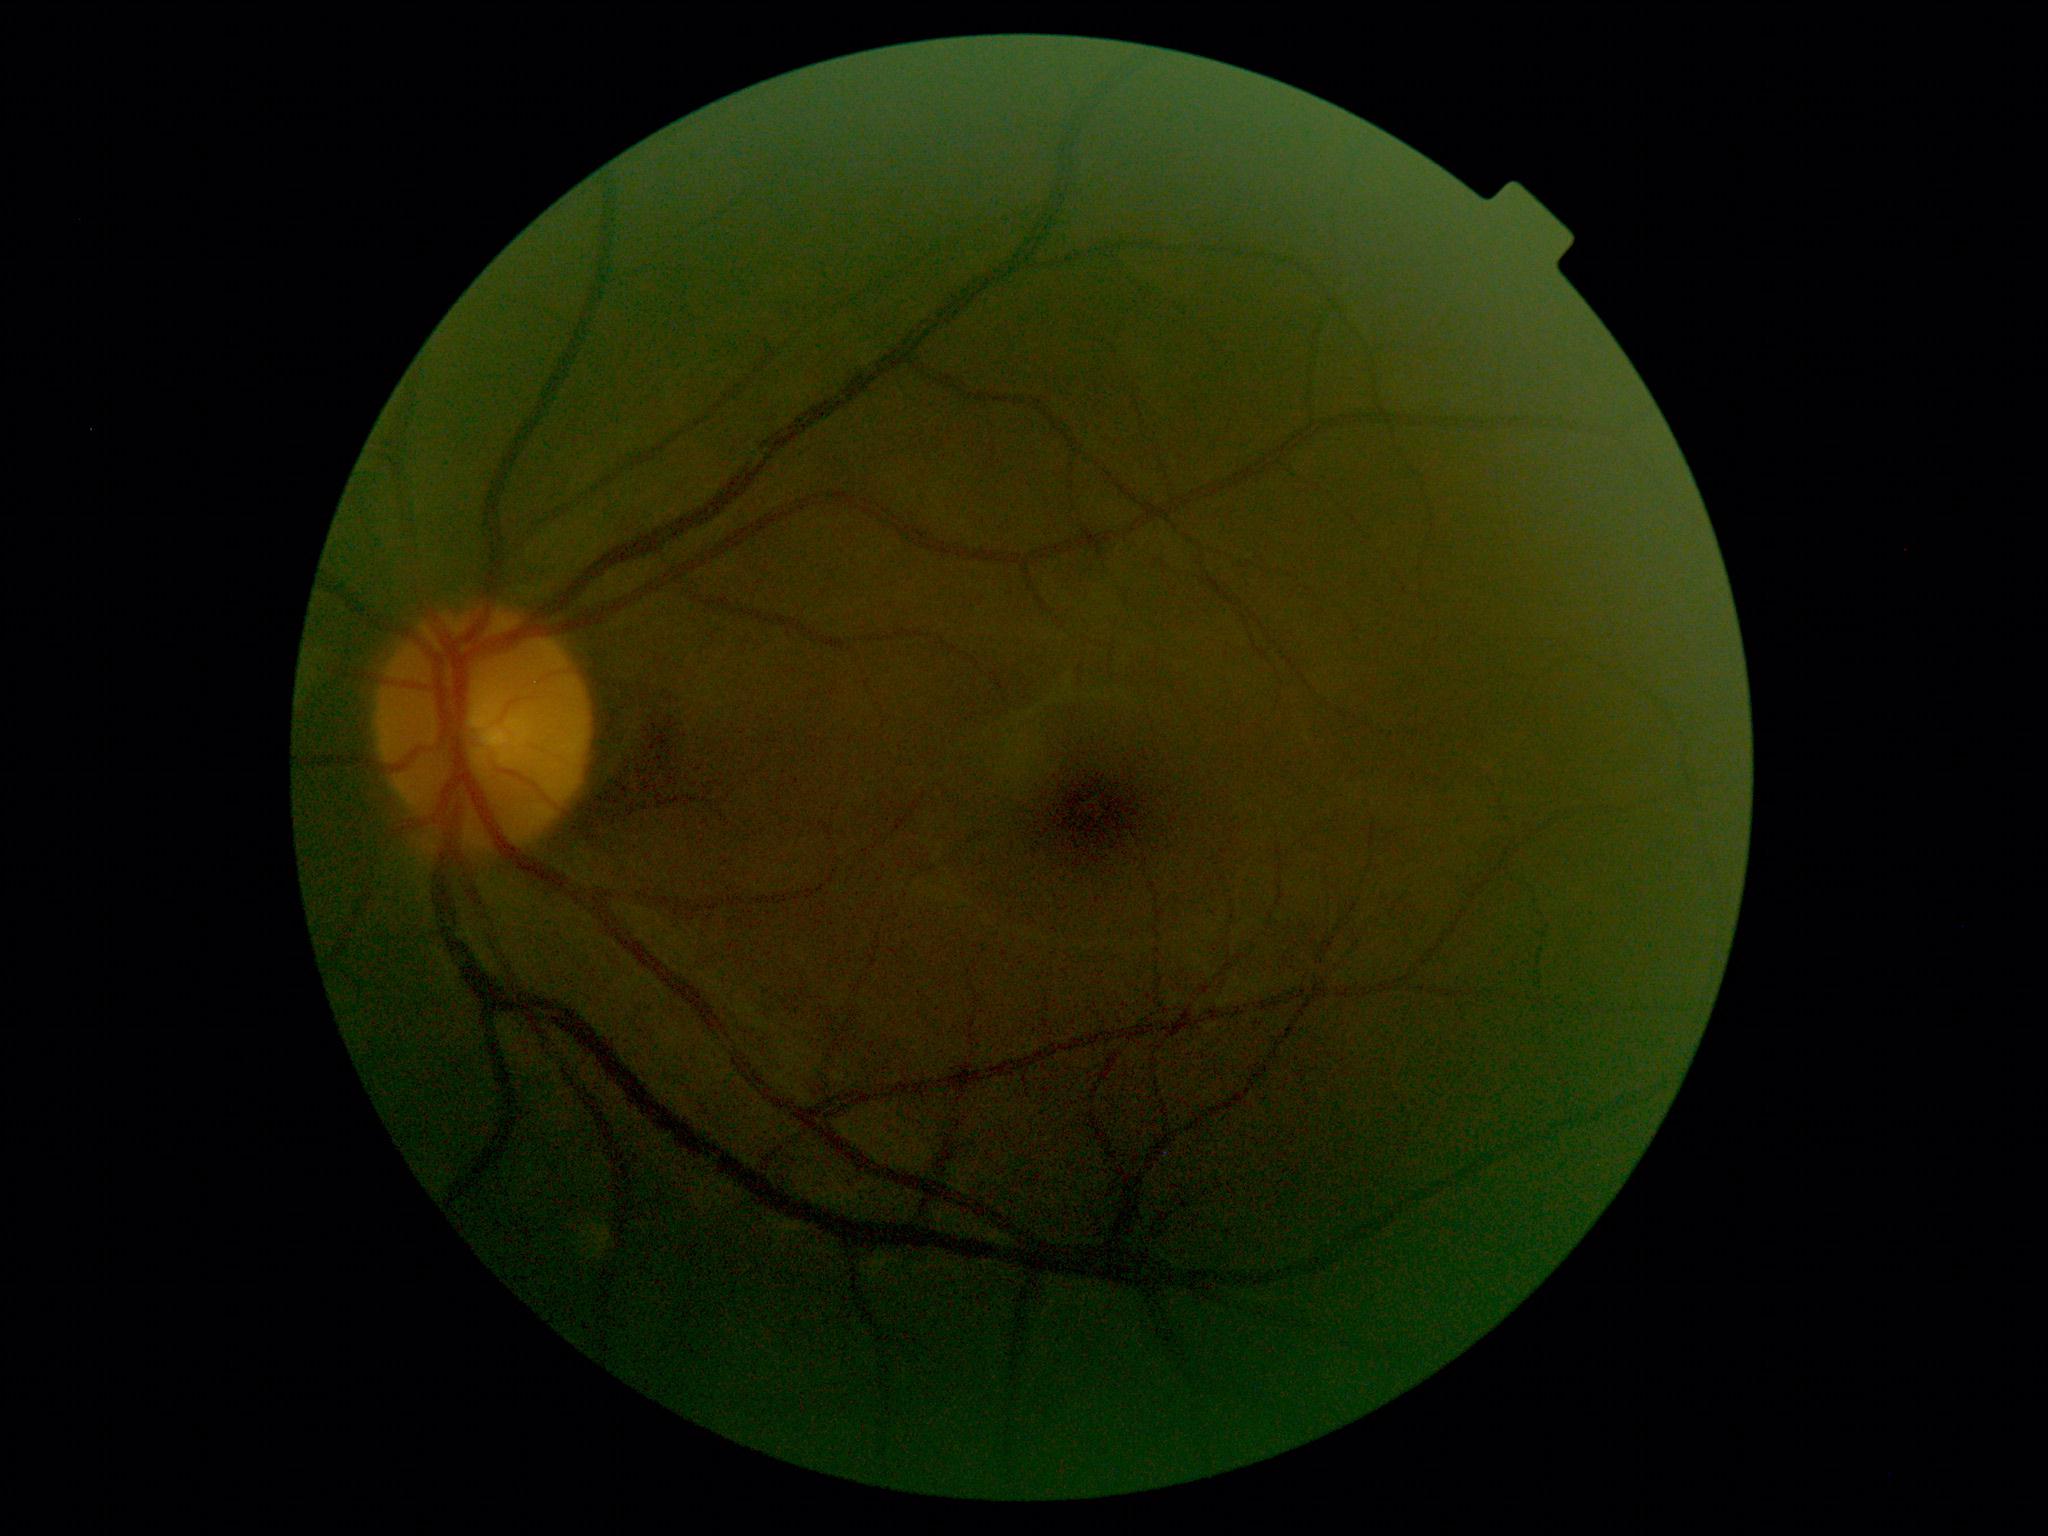

DR: 0 — no visible signs of diabetic retinopathy. No apparent diabetic retinopathy.